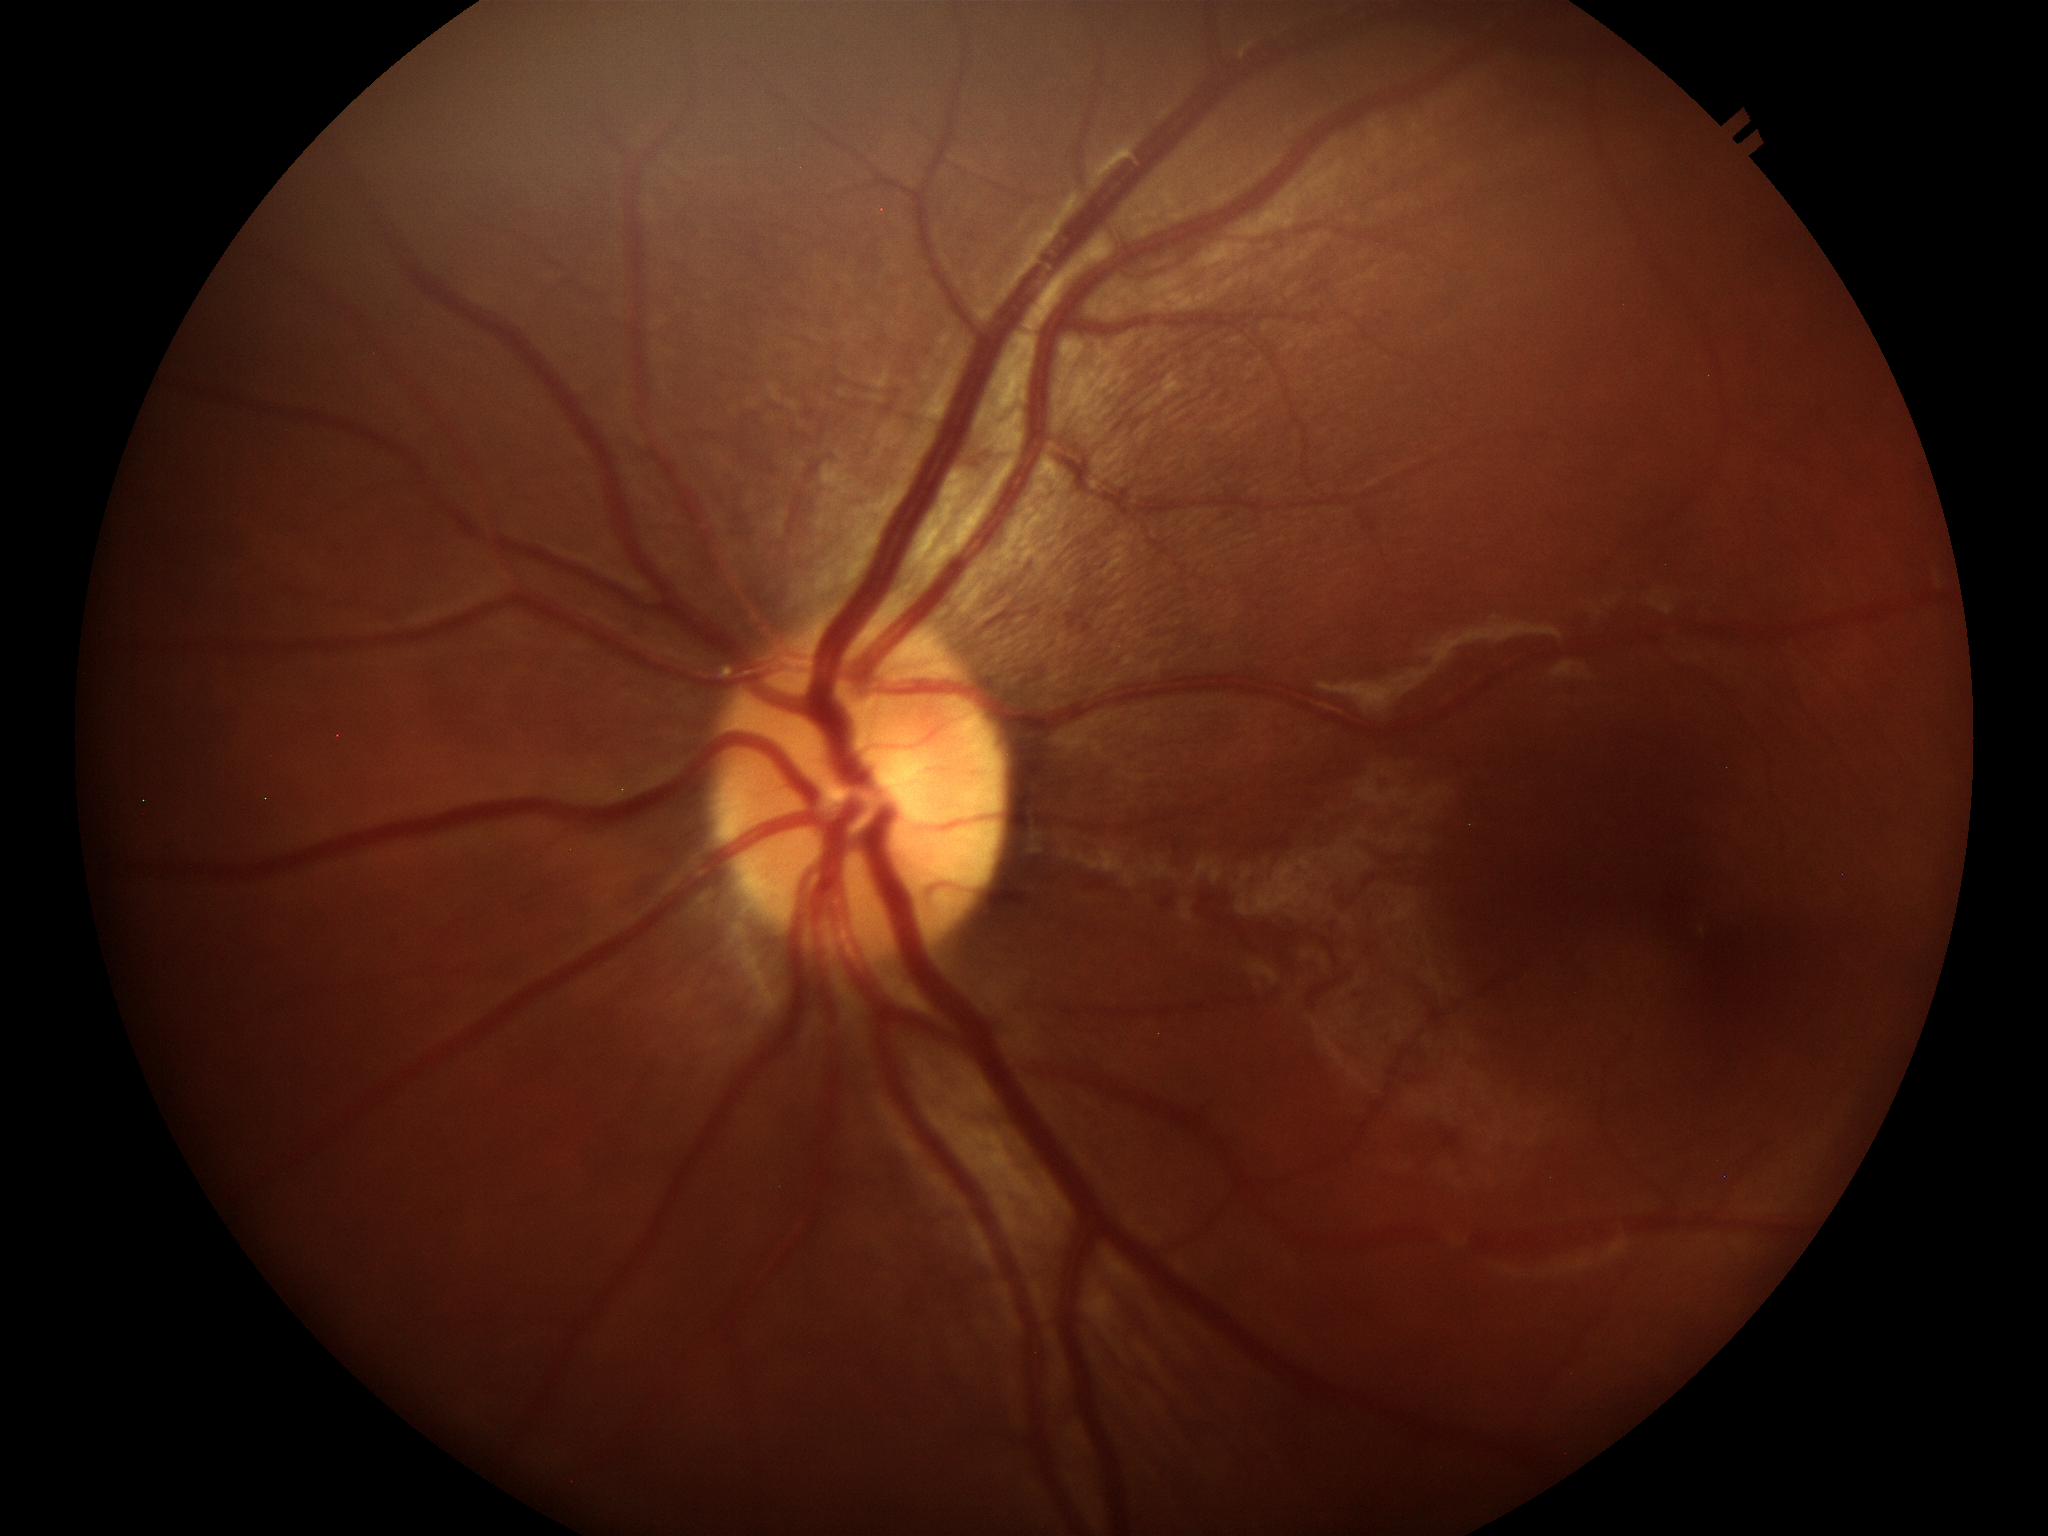

horizontal C/D ratio = 0.45 | vertical C/D ratio = 0.41 | Glaucoma decision = no suspicious findings.